240 by 240 pixels · non-mydriatic · optic disc region crop.
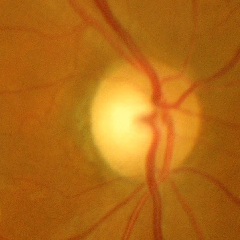

Showing advanced glaucomatous optic neuropathy. (Criteria: near-total cupping of the optic nerve head, with or without severe visual field loss within the central 10 degrees of fixation.)